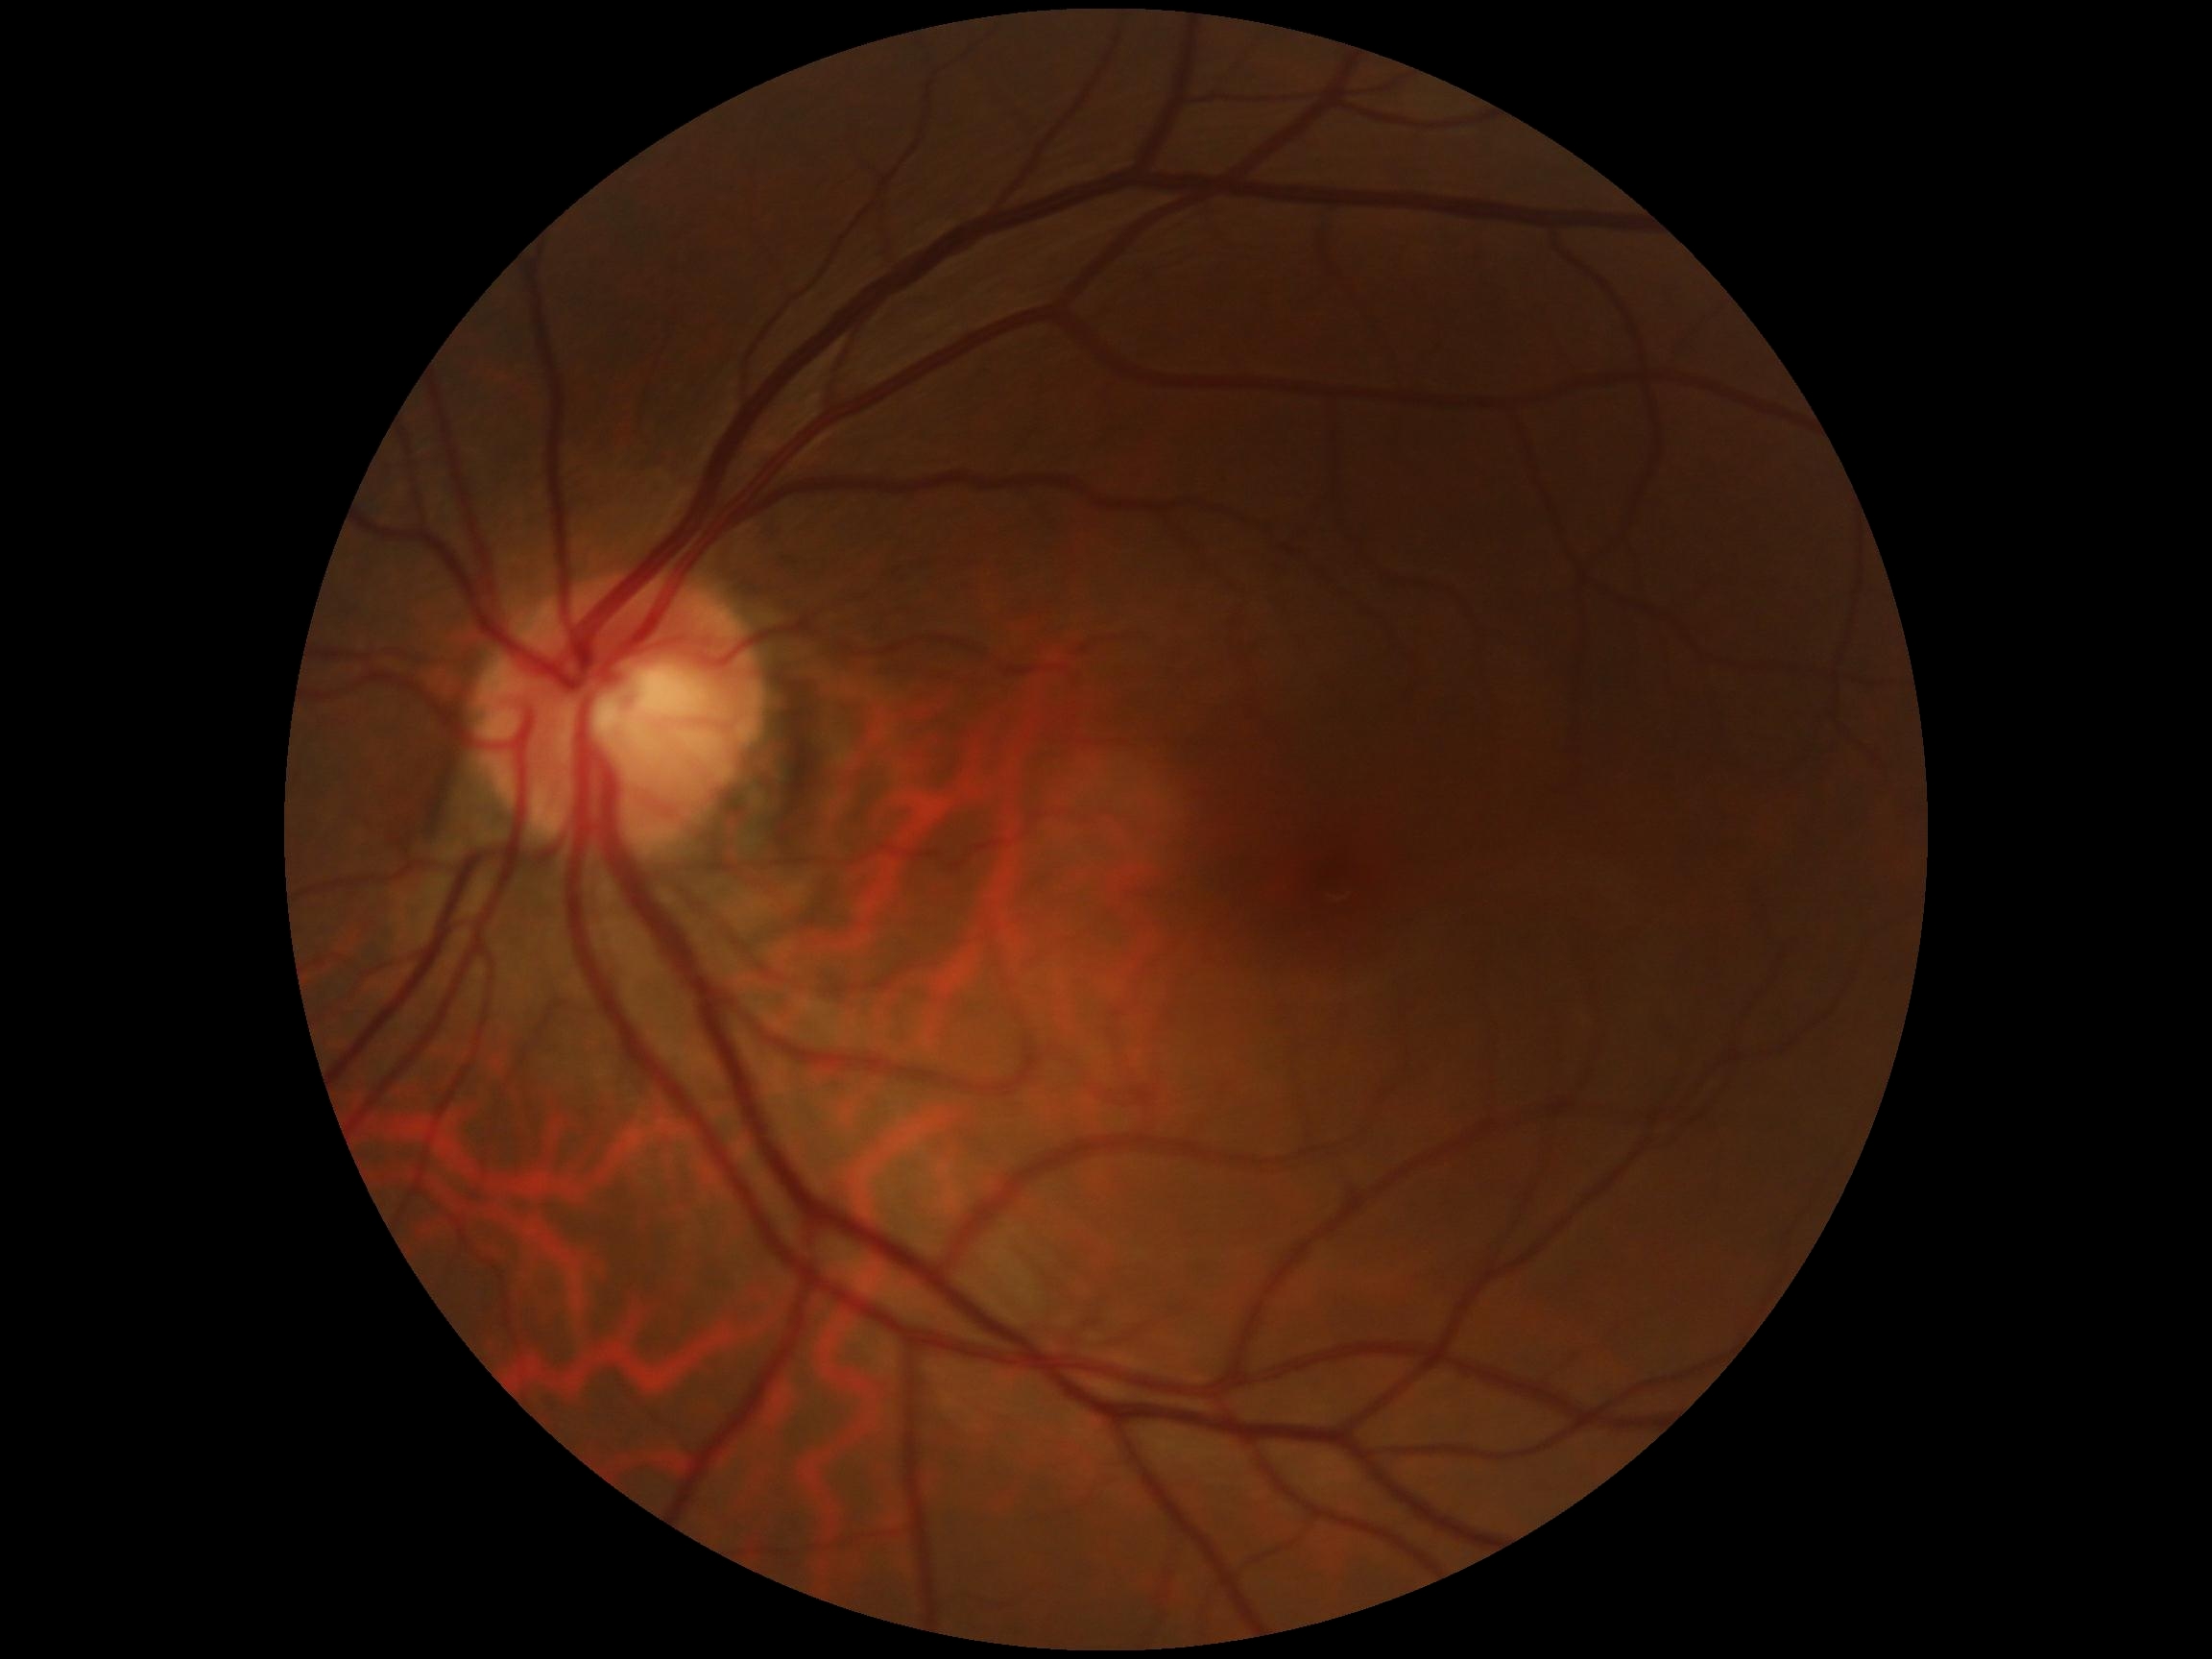

diabetic retinopathy (DR)@grade 0 (no apparent retinopathy).